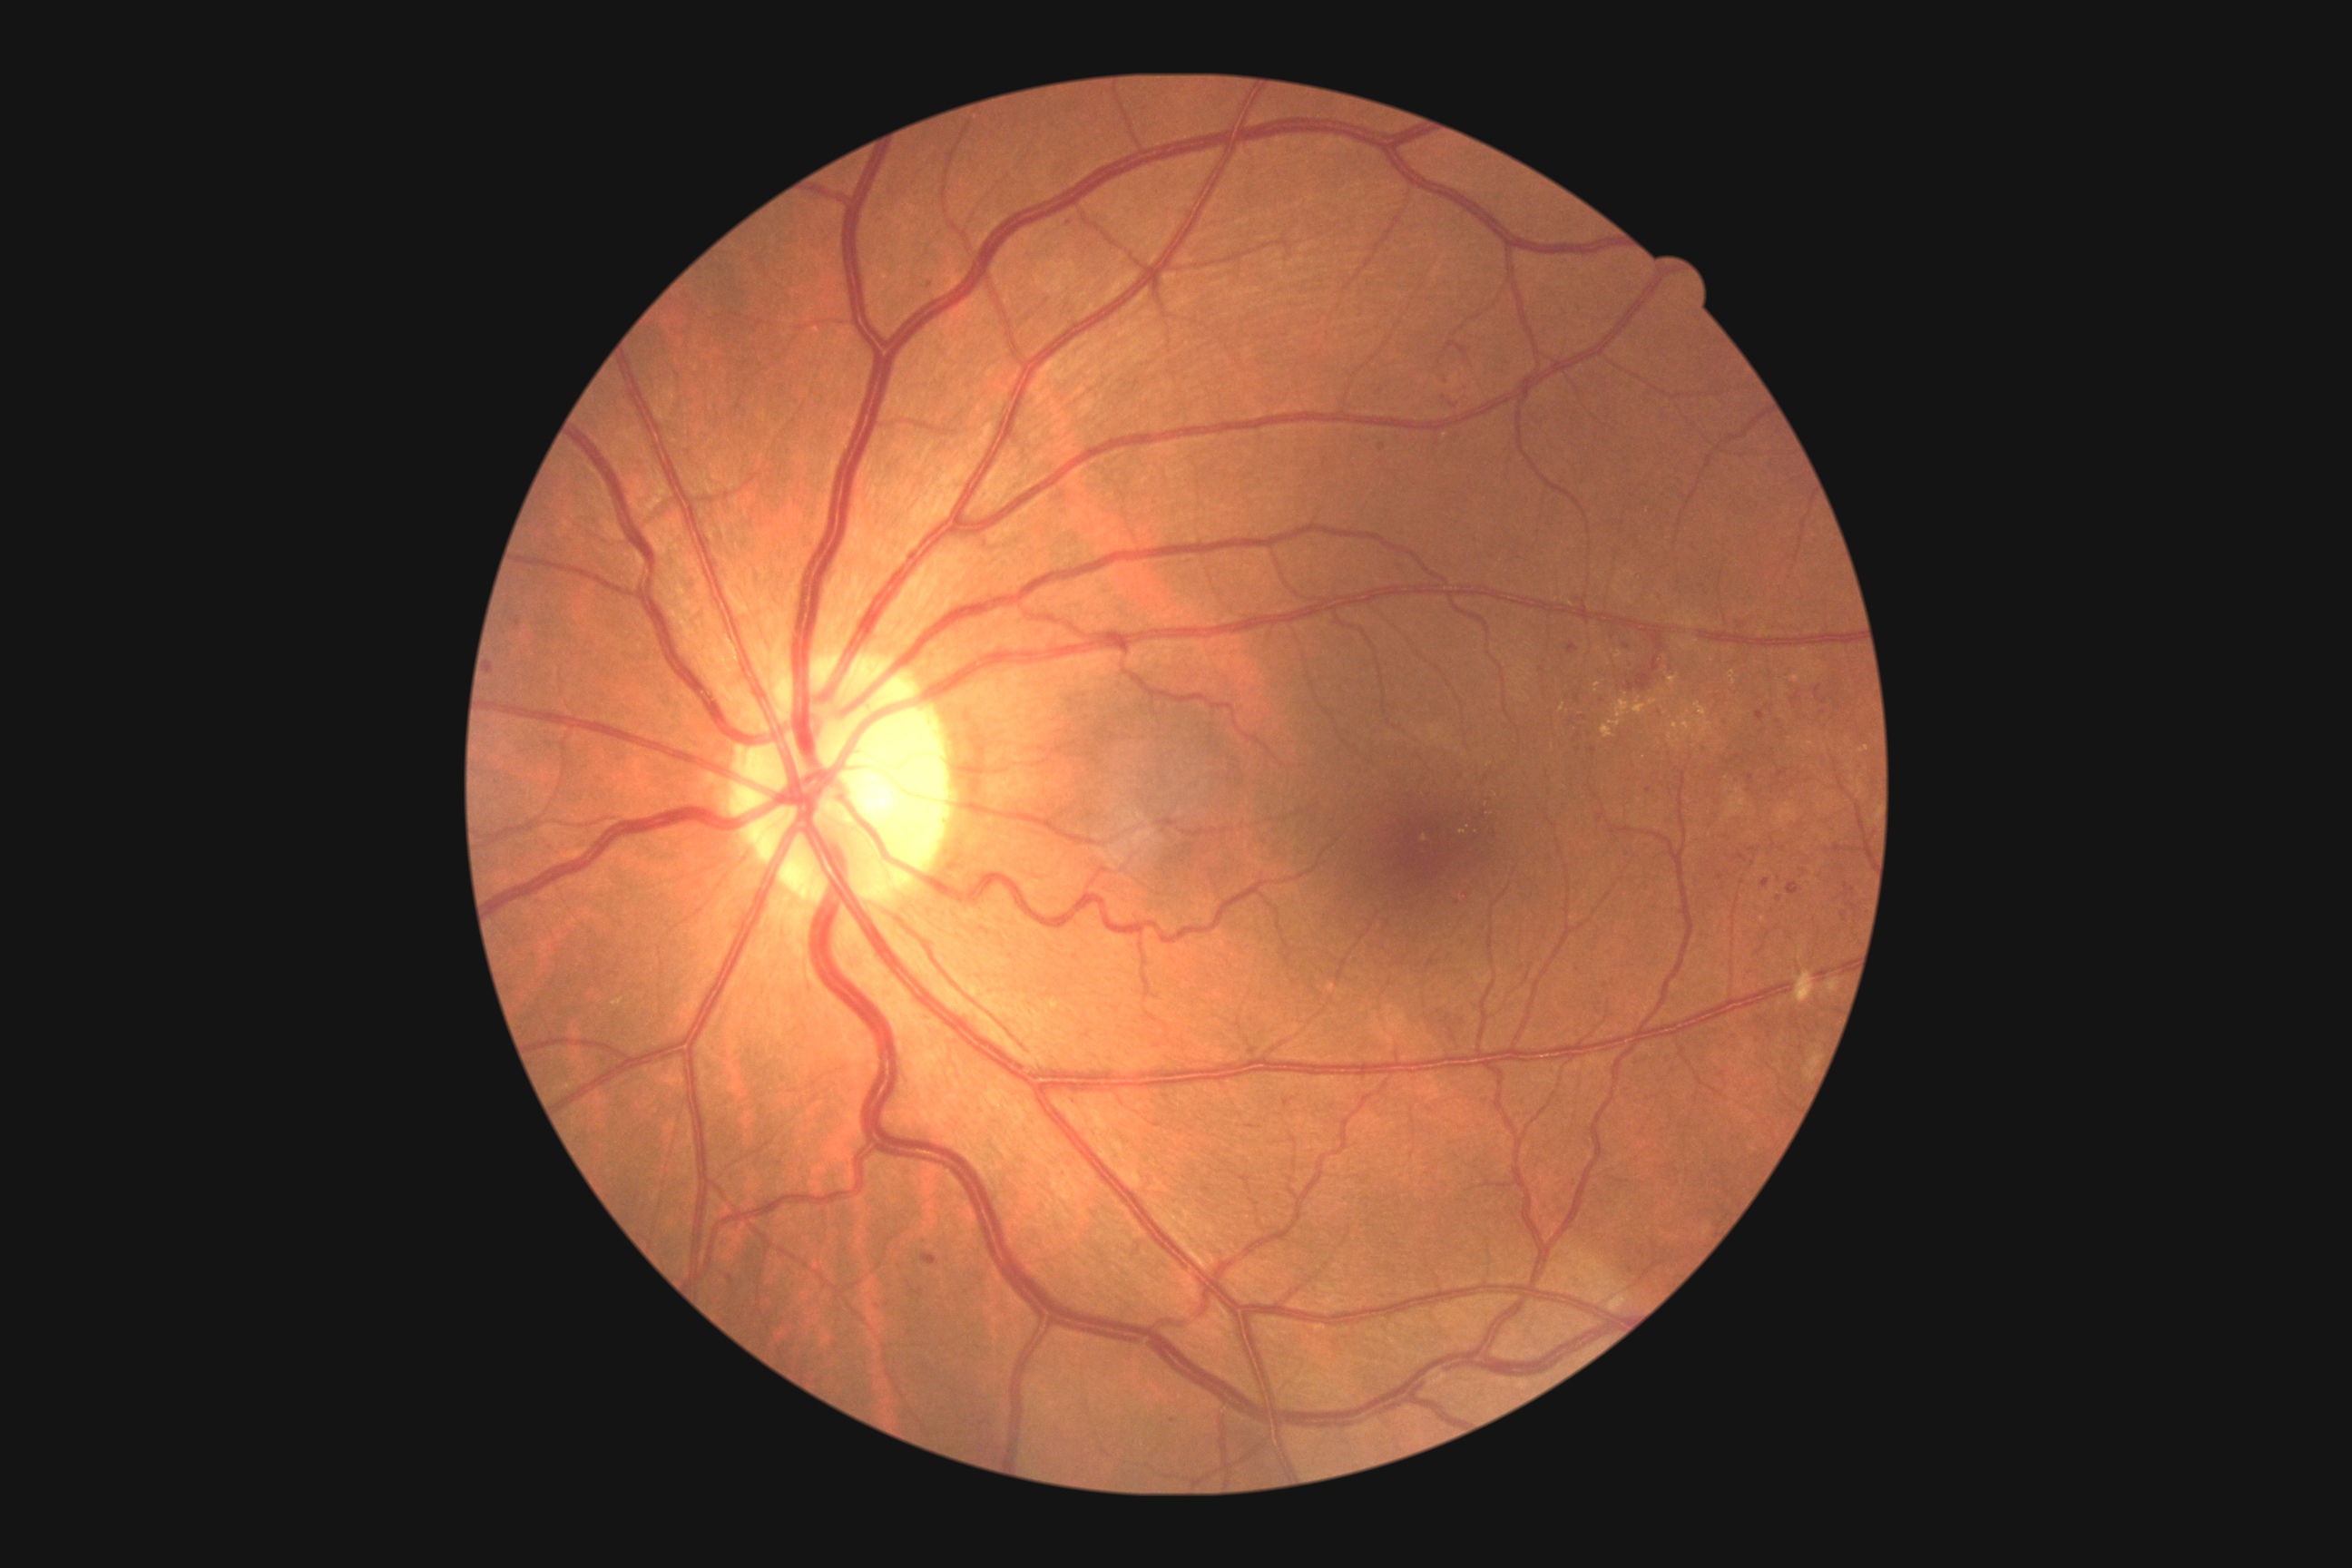

DR stage: grade 2
A subset of detected lesions:
EXs (more not shown) = 1681, 721, 1692, 732; 1609, 700, 1631, 727; 1792, 674, 1801, 681; 1859, 747, 1870, 754; 1596, 683, 1602, 692; 1602, 725, 1614, 740; 1803, 741, 1814, 750
Smaller EXs around [1633, 656]; [1627, 696]; [1562, 708]; [1445, 436]
HEs (more not shown) = 1066, 217, 1077, 226; 925, 279, 936, 289; 1841, 912, 1847, 923; 1732, 756, 1740, 763; 1790, 694, 1801, 703; 1578, 747, 1585, 758; 1442, 395, 1469, 409; 1734, 776, 1743, 787; 1591, 747, 1596, 756; 1787, 883, 1799, 896; 1778, 770, 1788, 778
Smaller HEs around [1649, 790]; [1173, 1421]; [1383, 449]; [1778, 724]; [1825, 702]